Acquired with a NIDEK AFC-230 · no pharmacologic dilation · 848x848px
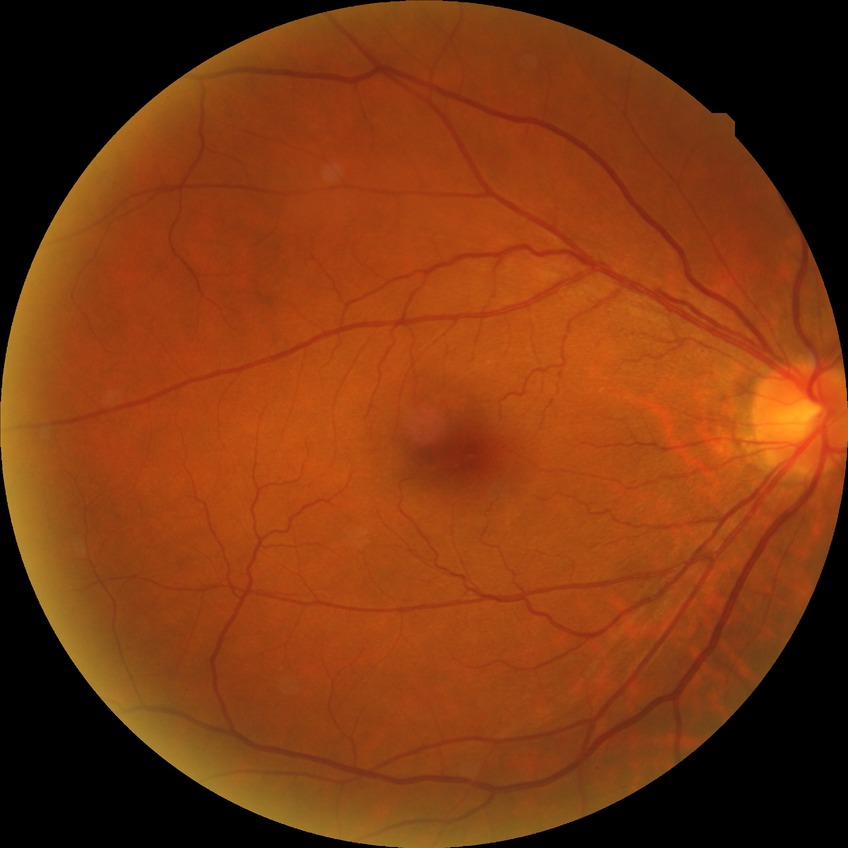 Annotations:
– DR impression — no DR findings
– DR severity — NDR